Retinal fundus photograph; nonmydriatic; NIDEK AFC-230.
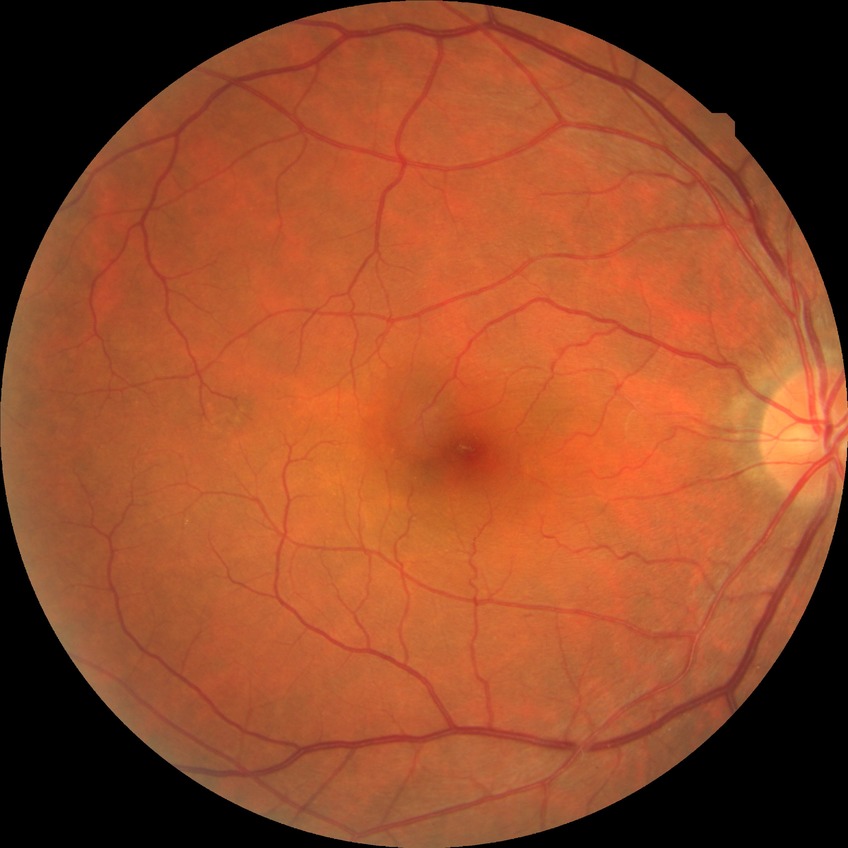
Modified Davis classification is no diabetic retinopathy.